1932 by 1932 pixels. Captured after pupil dilation
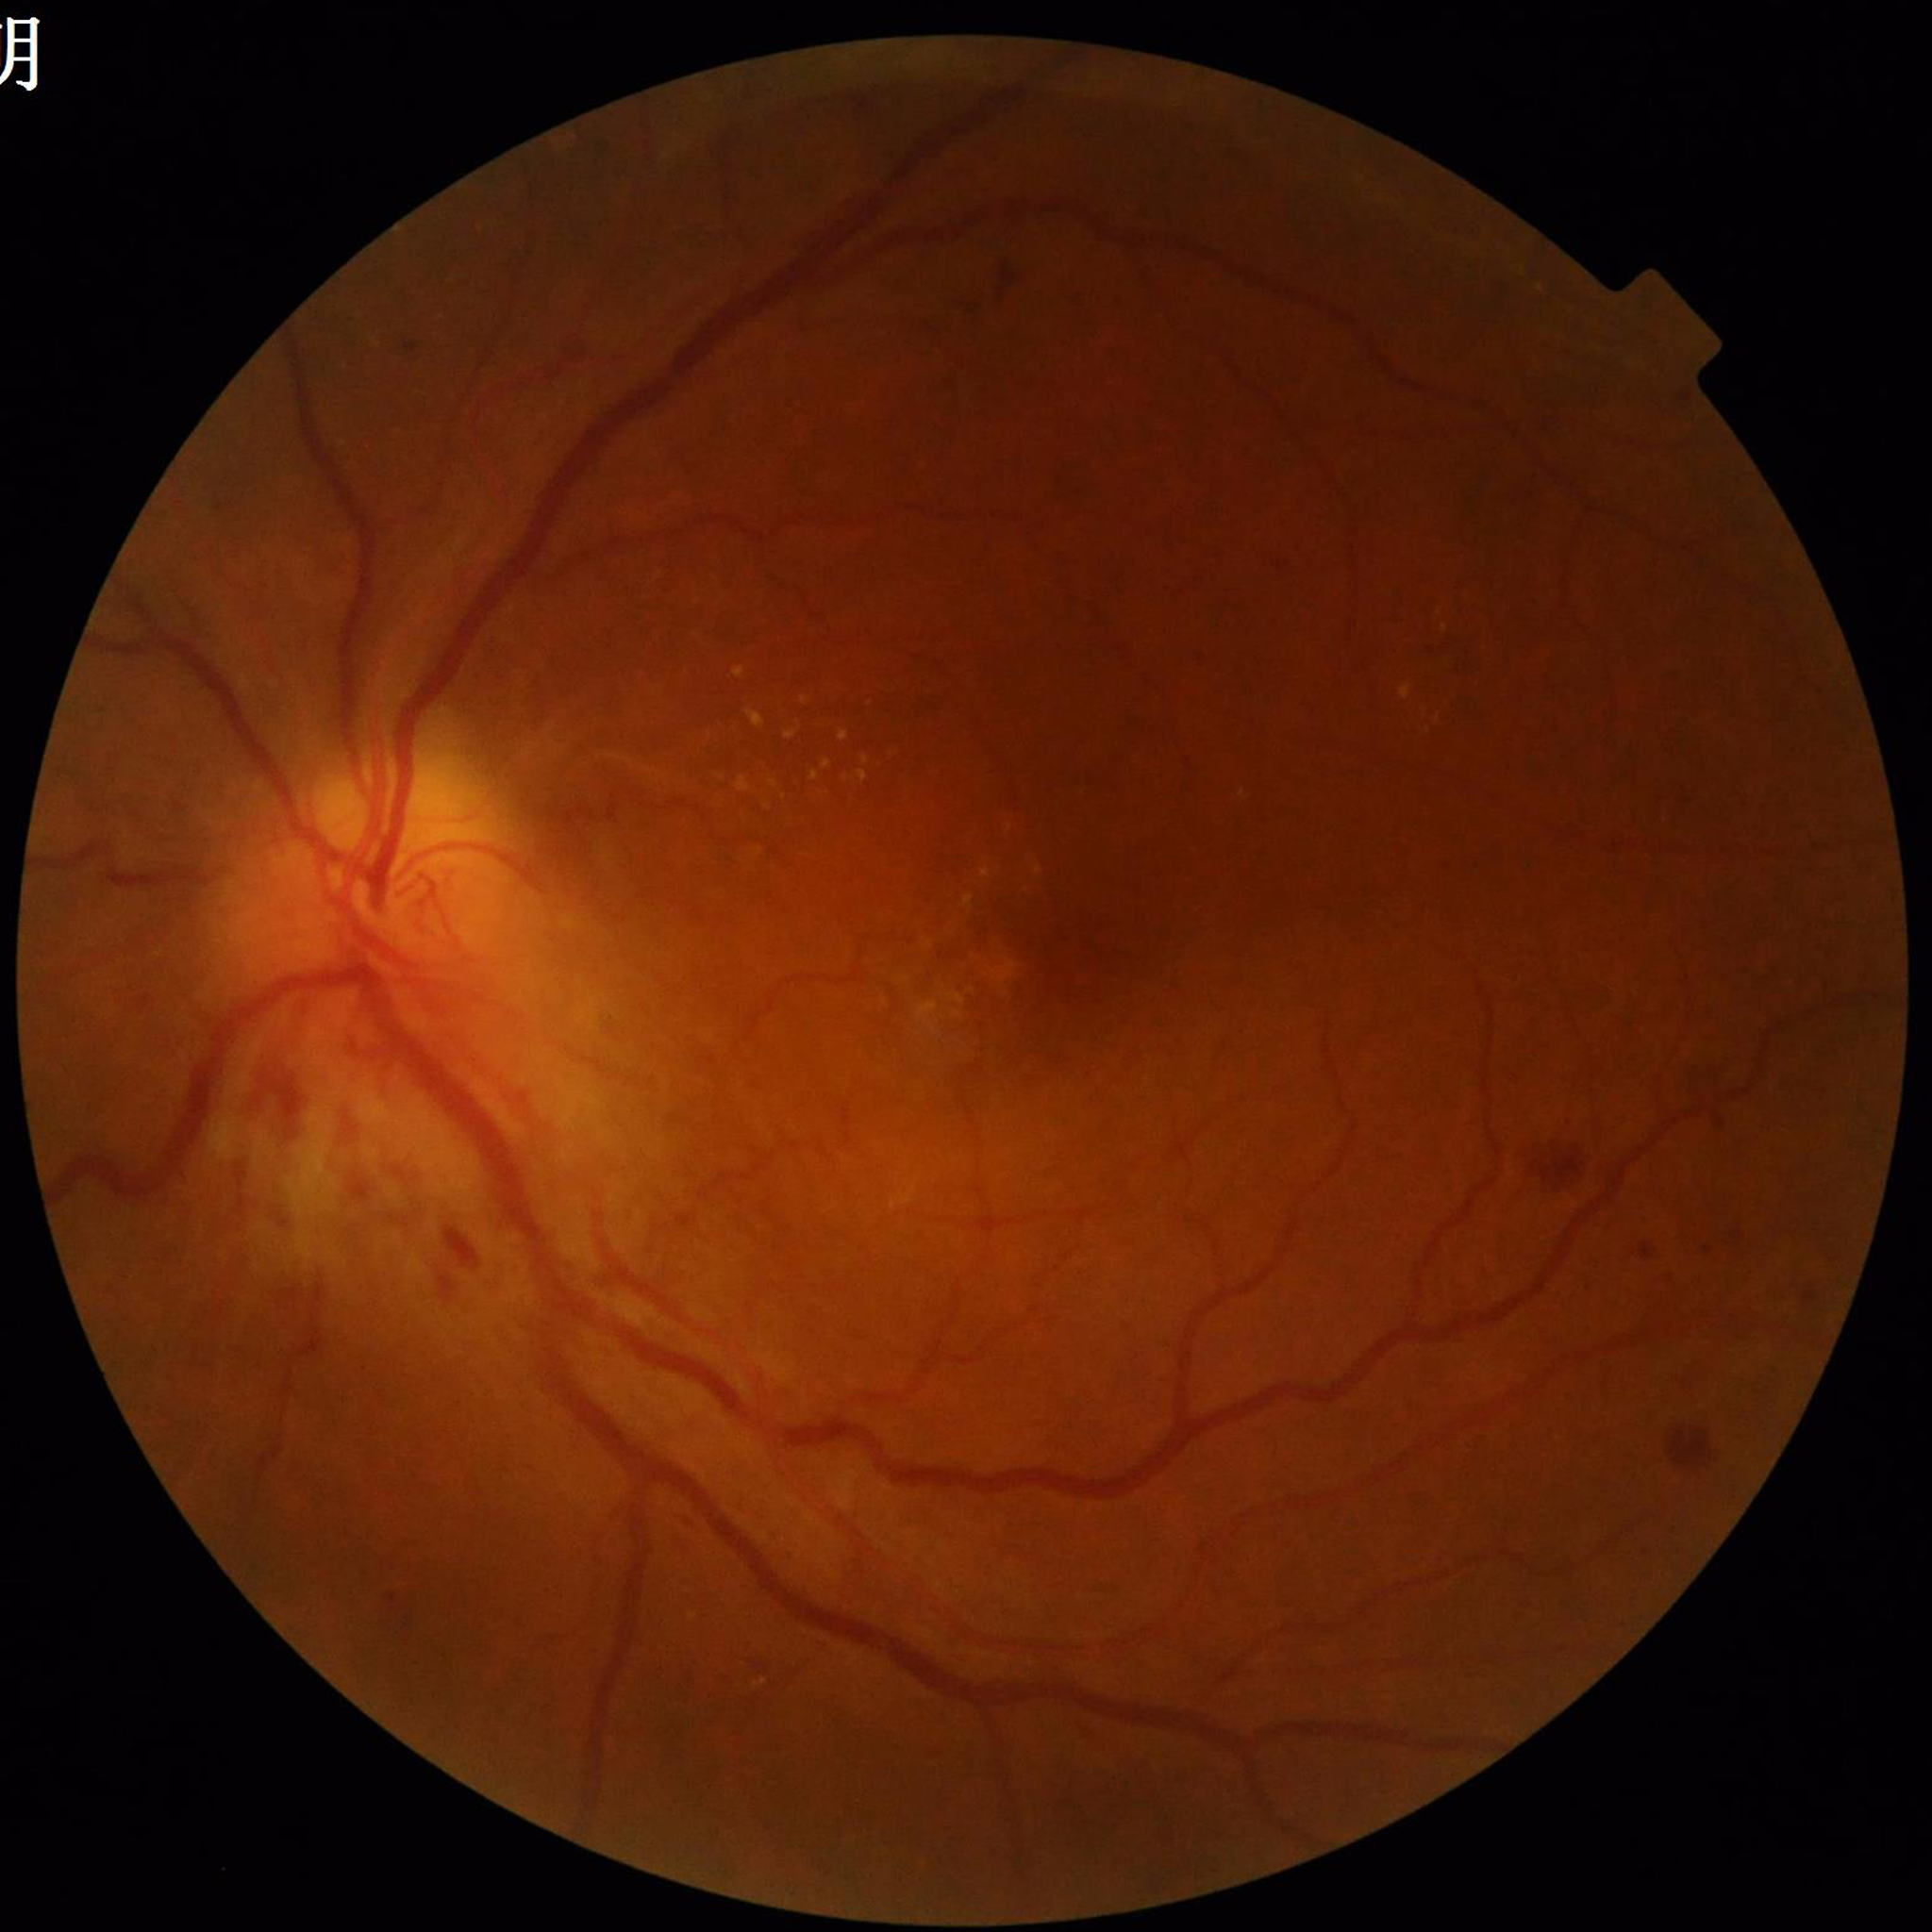

Diagnosis = diabetic retinopathy
Photo quality = contrast adequate, illumination and color satisfactory, no blur